Color fundus photograph. 45-degree field of view. 2048 by 1536 pixels — 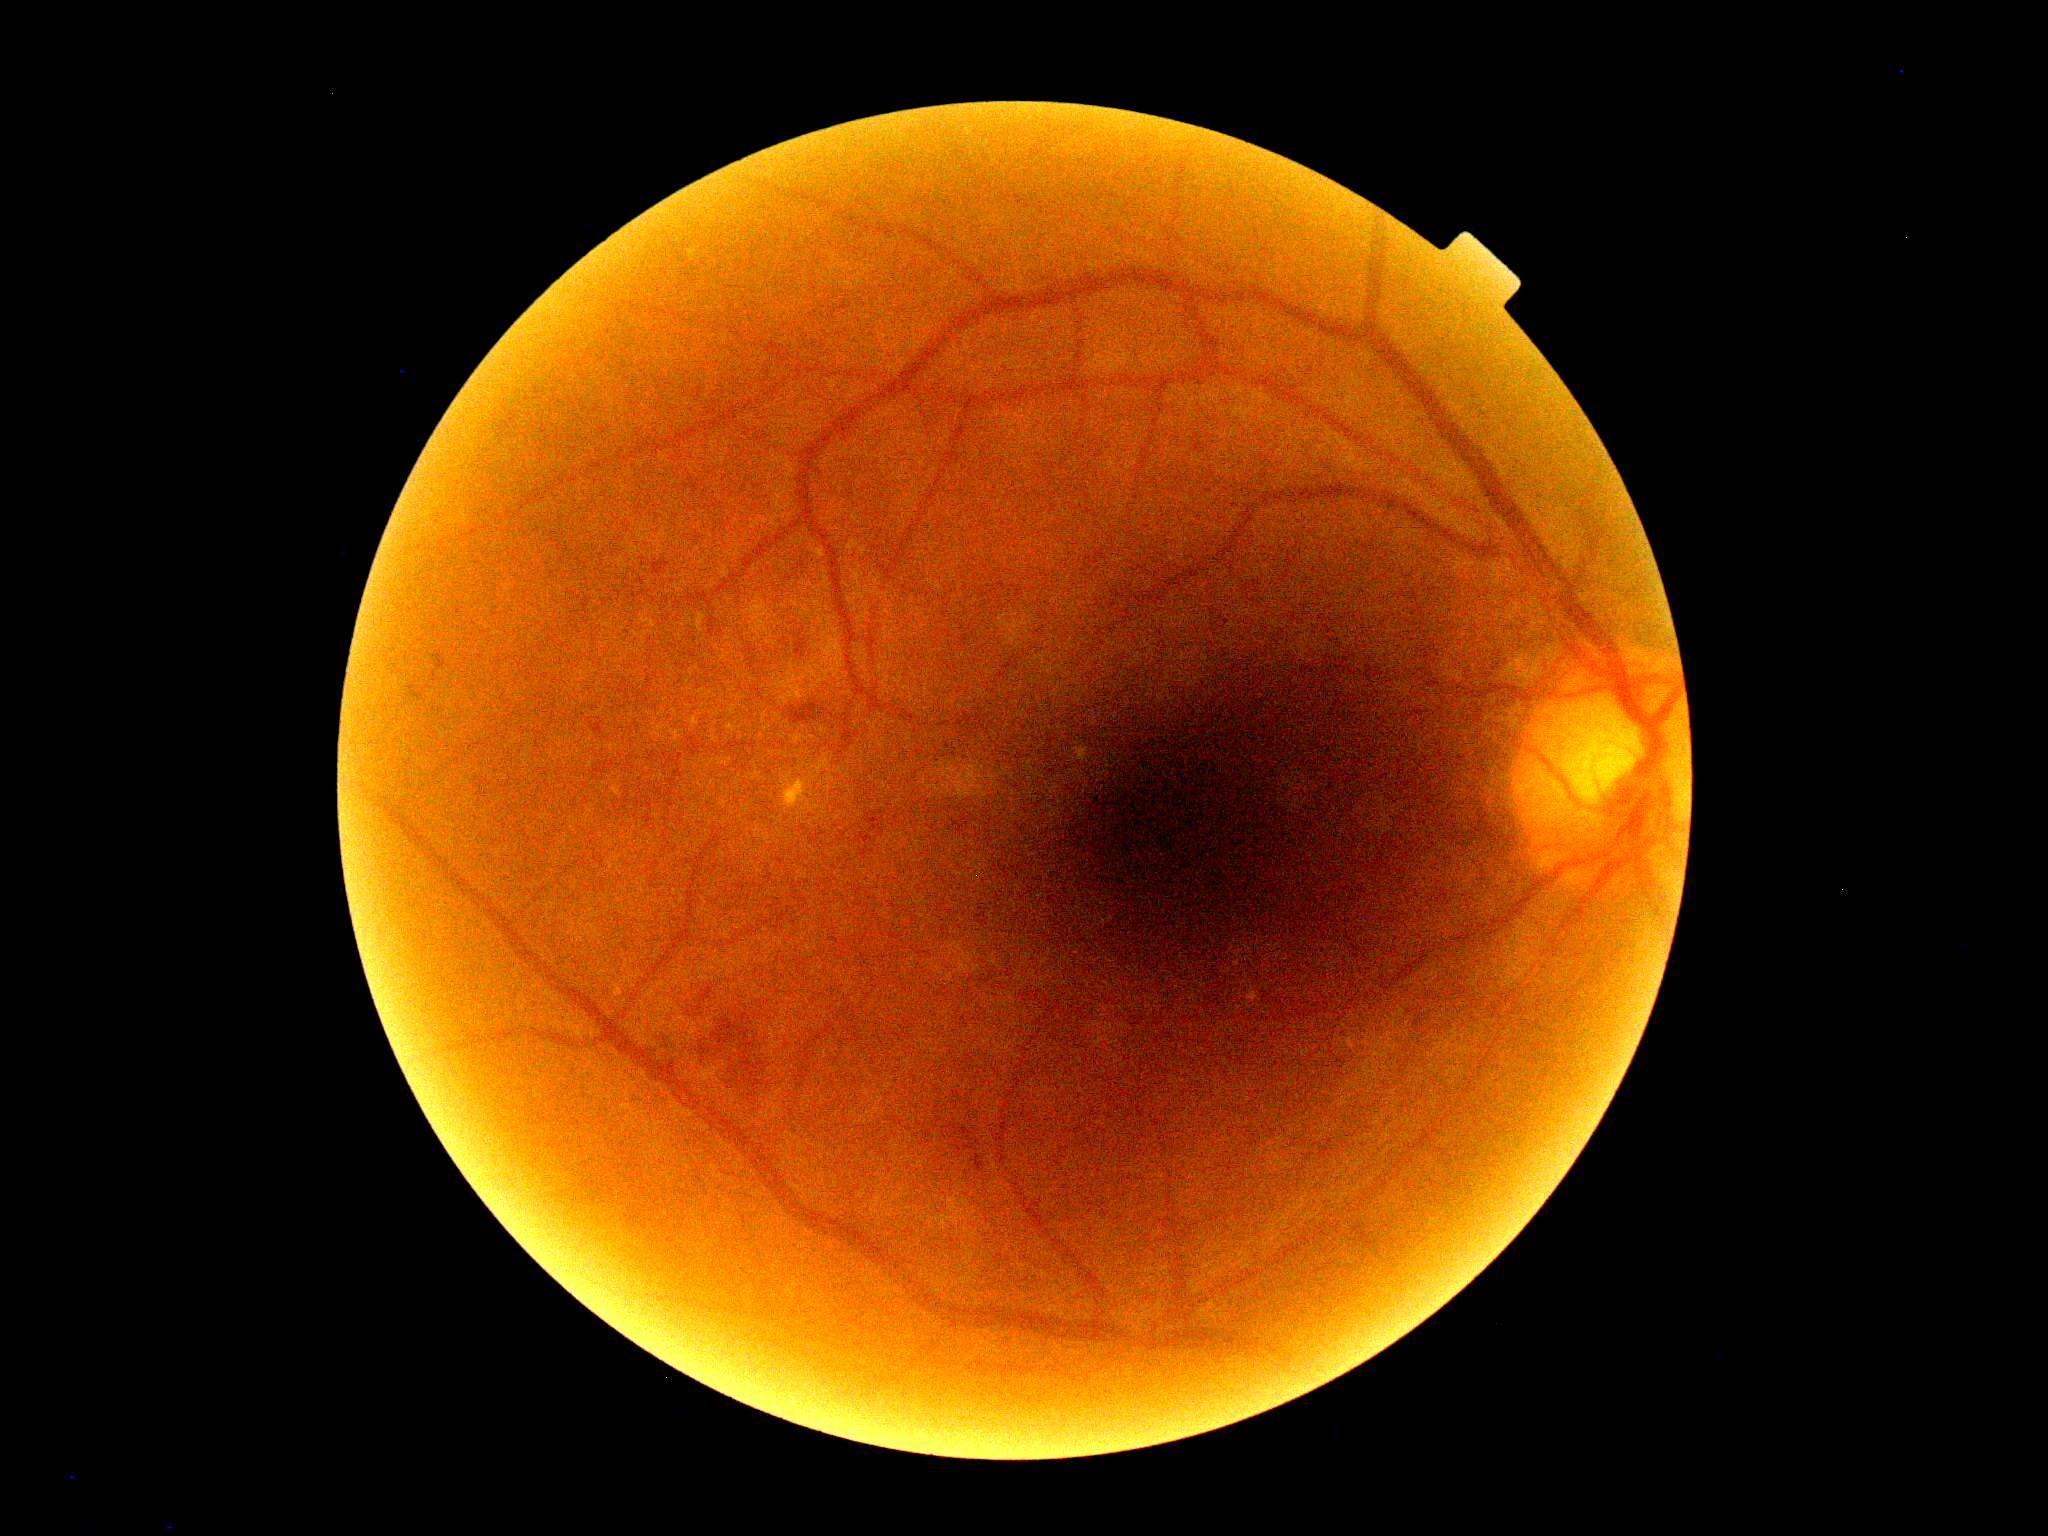

DR: 2 — more than just microaneurysms but less than severe NPDR.